Wide-field contact fundus photograph of an infant; image size 1440x1080: 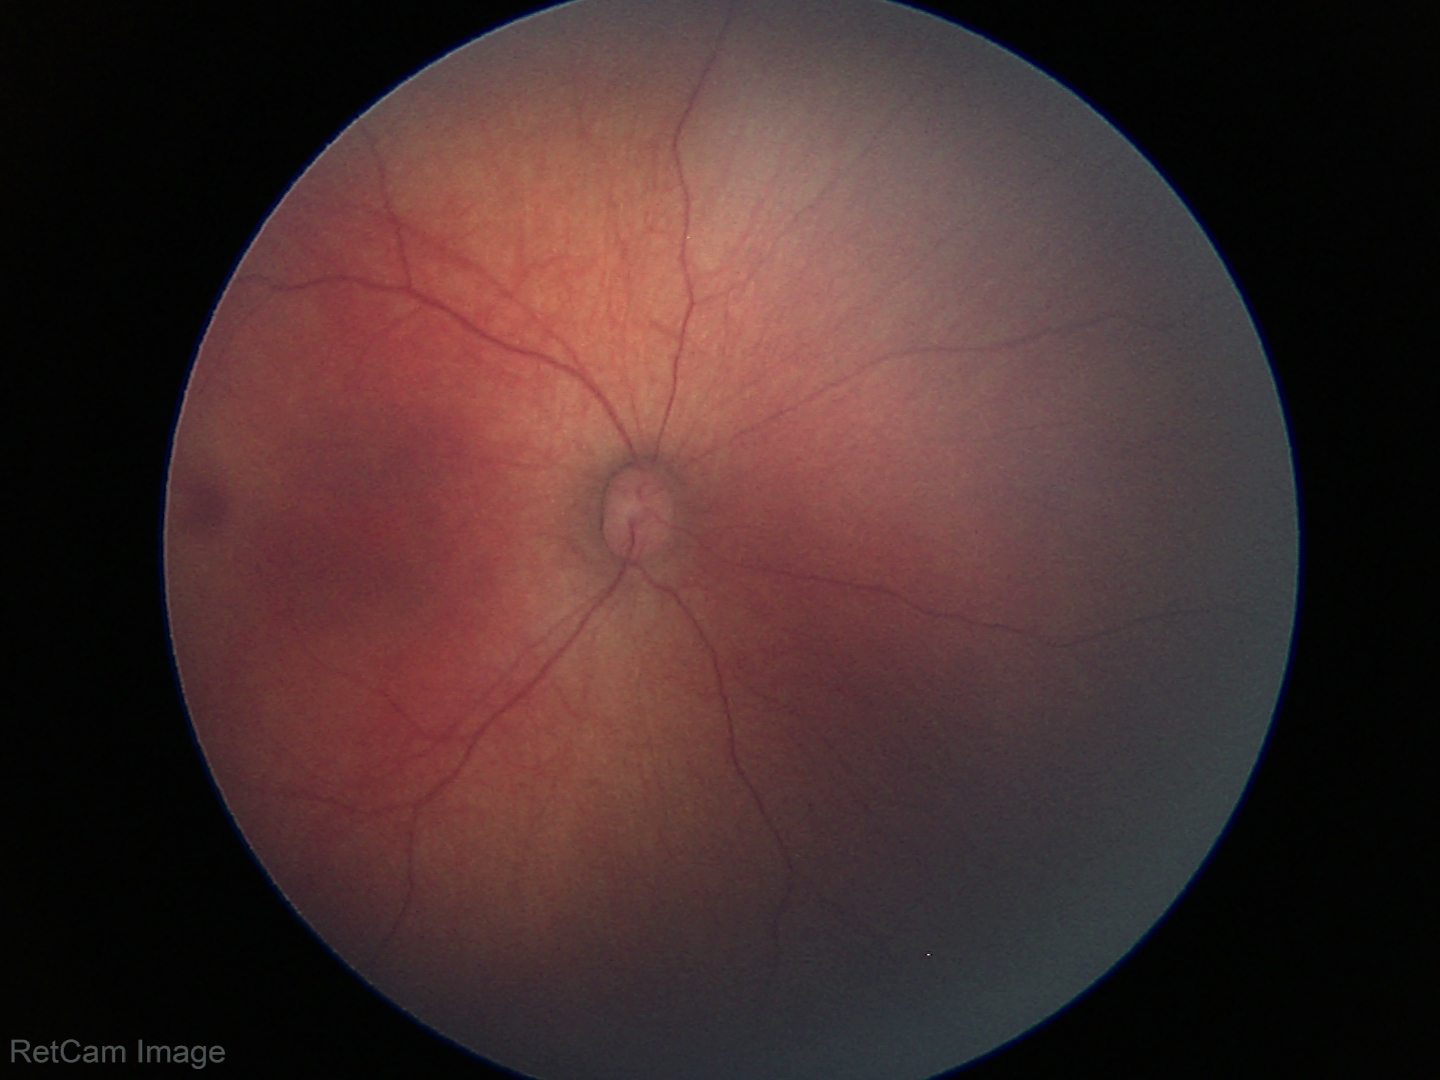

Screening diagnosis = no pathology identified.